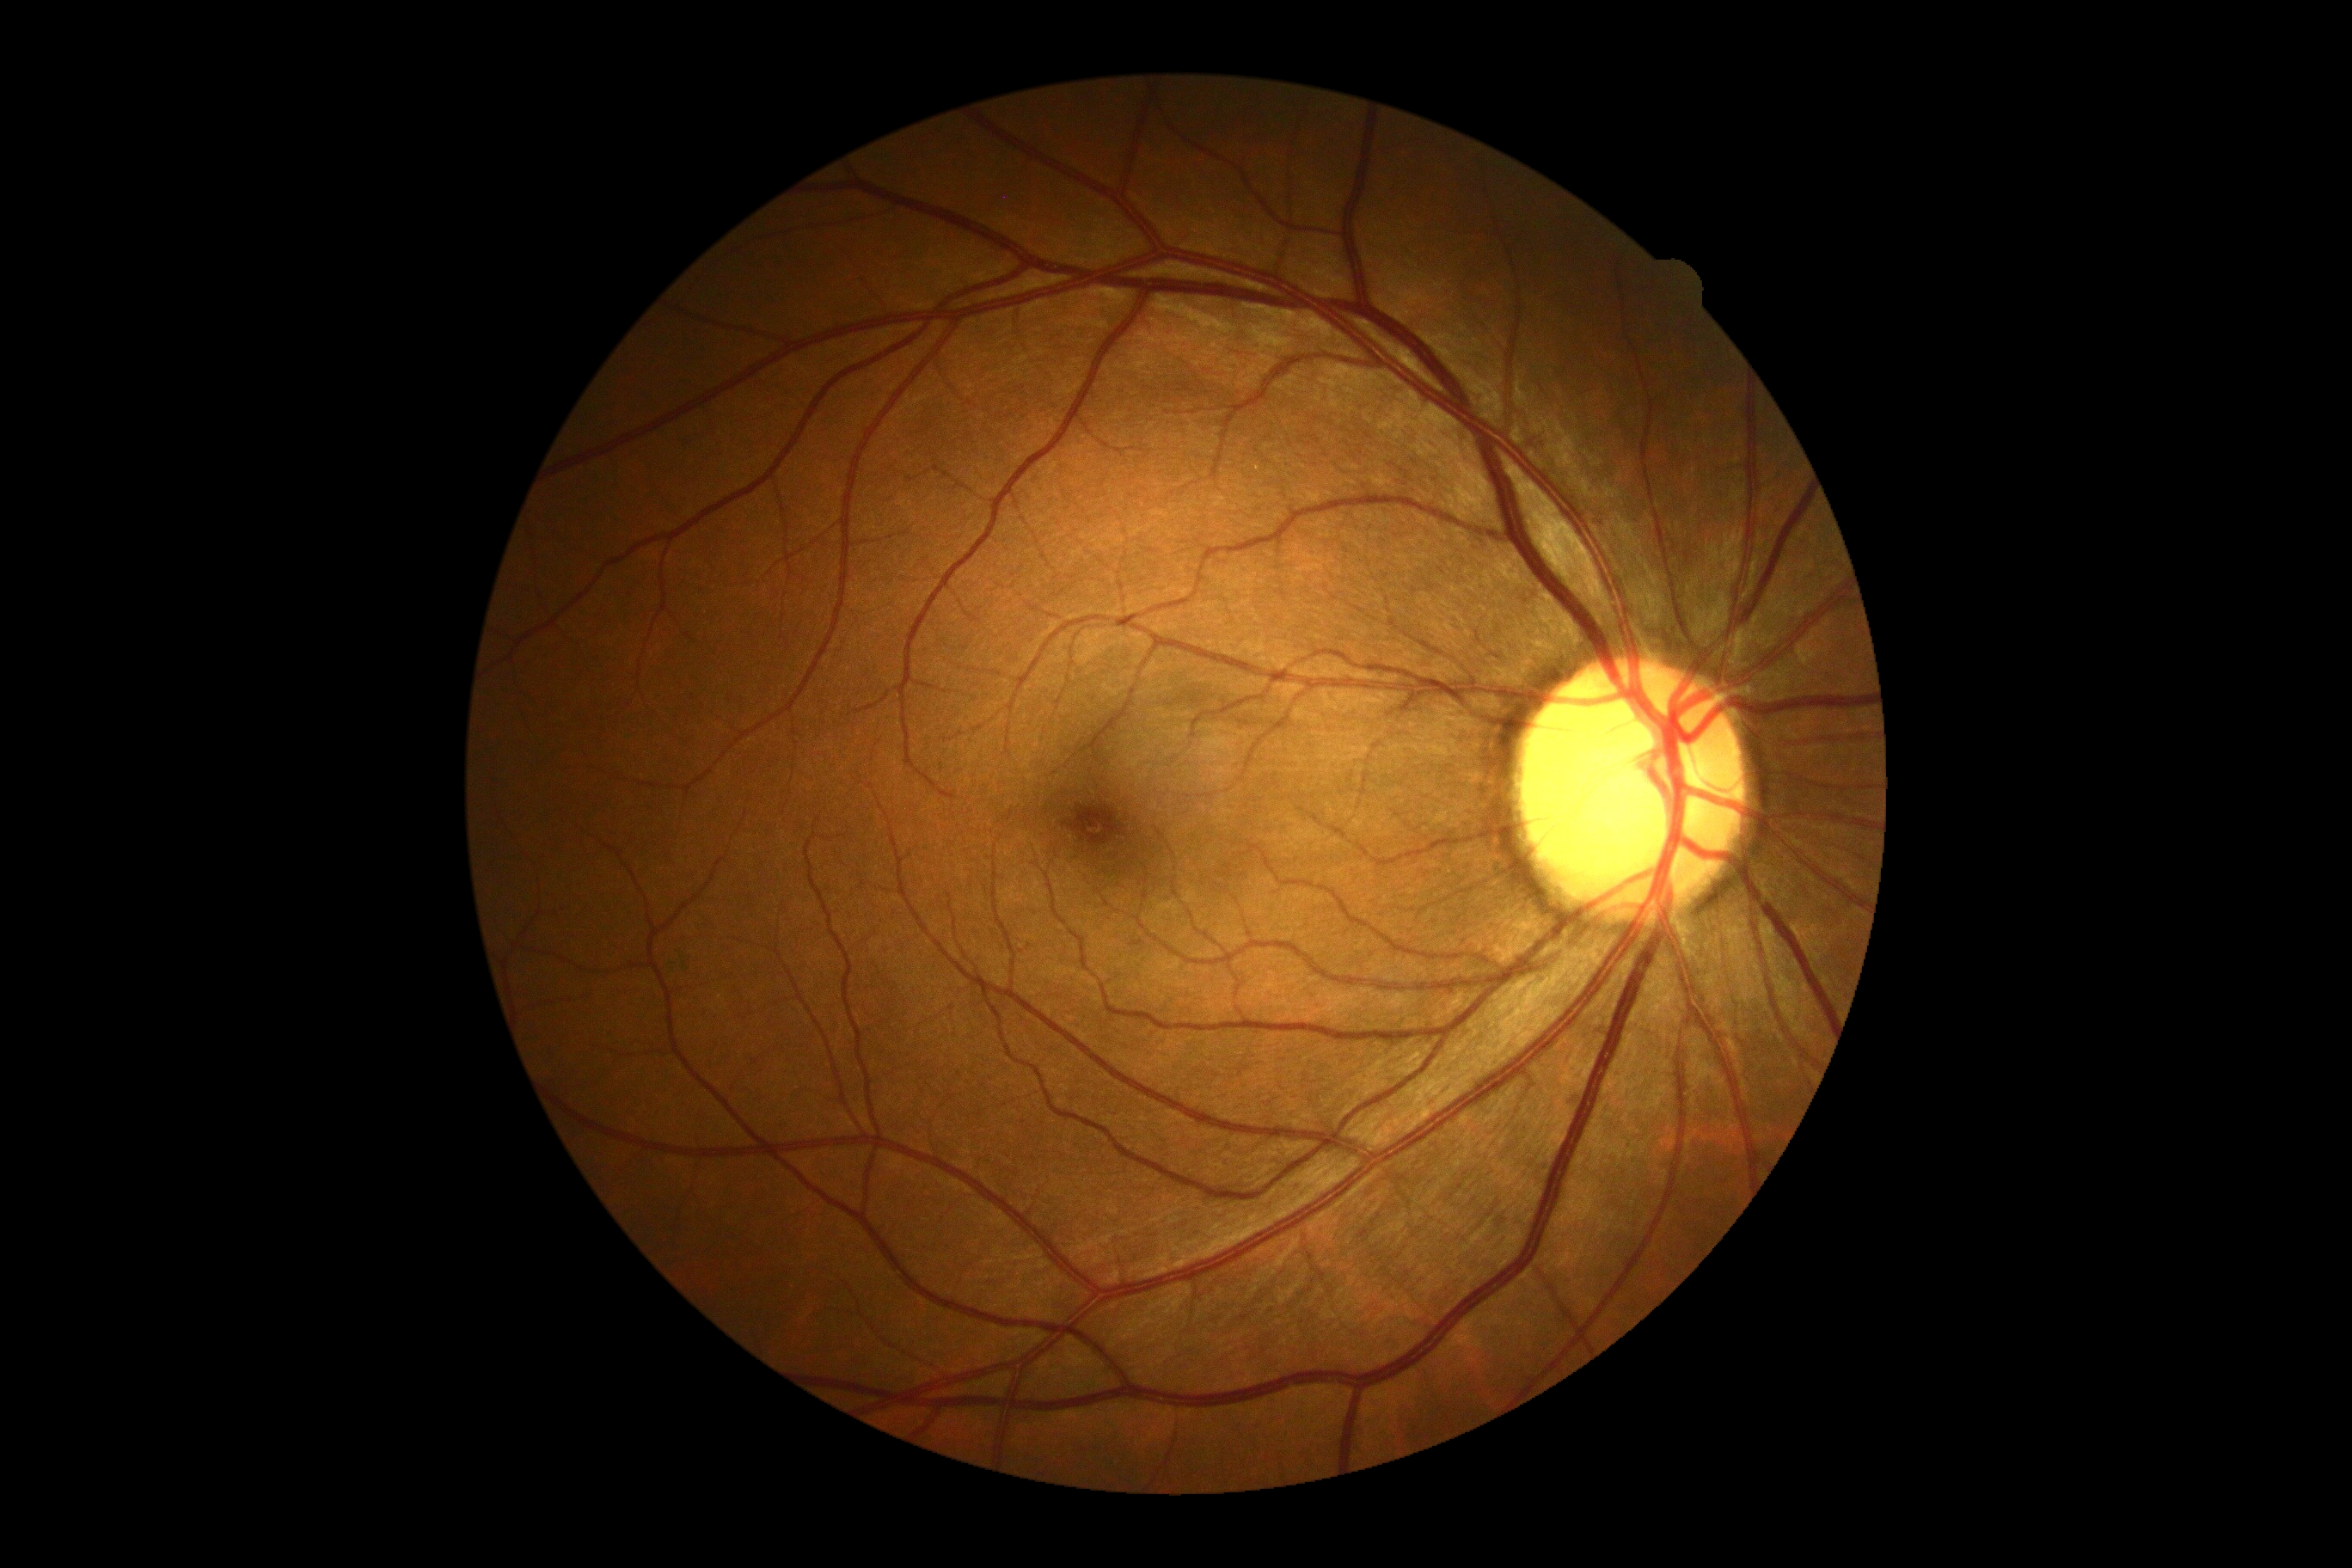
dr_impression: no apparent DR
dr_grade: grade 0